Posterior pole color fundus photograph · no pharmacologic dilation · 45° field of view
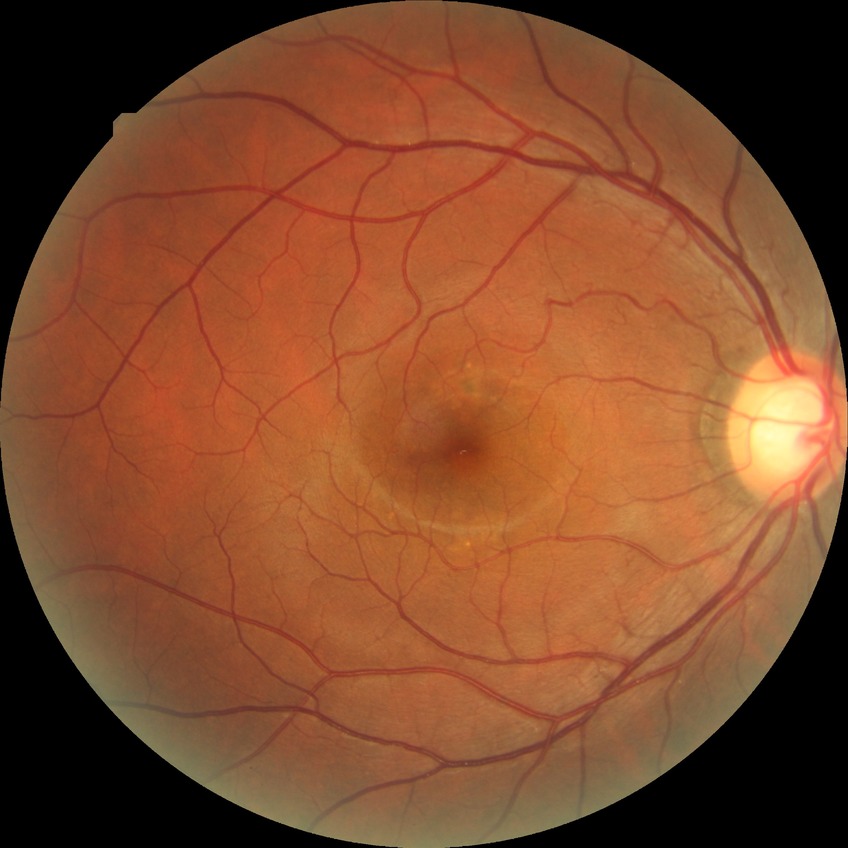
modified Davis classification: no diabetic retinopathy.